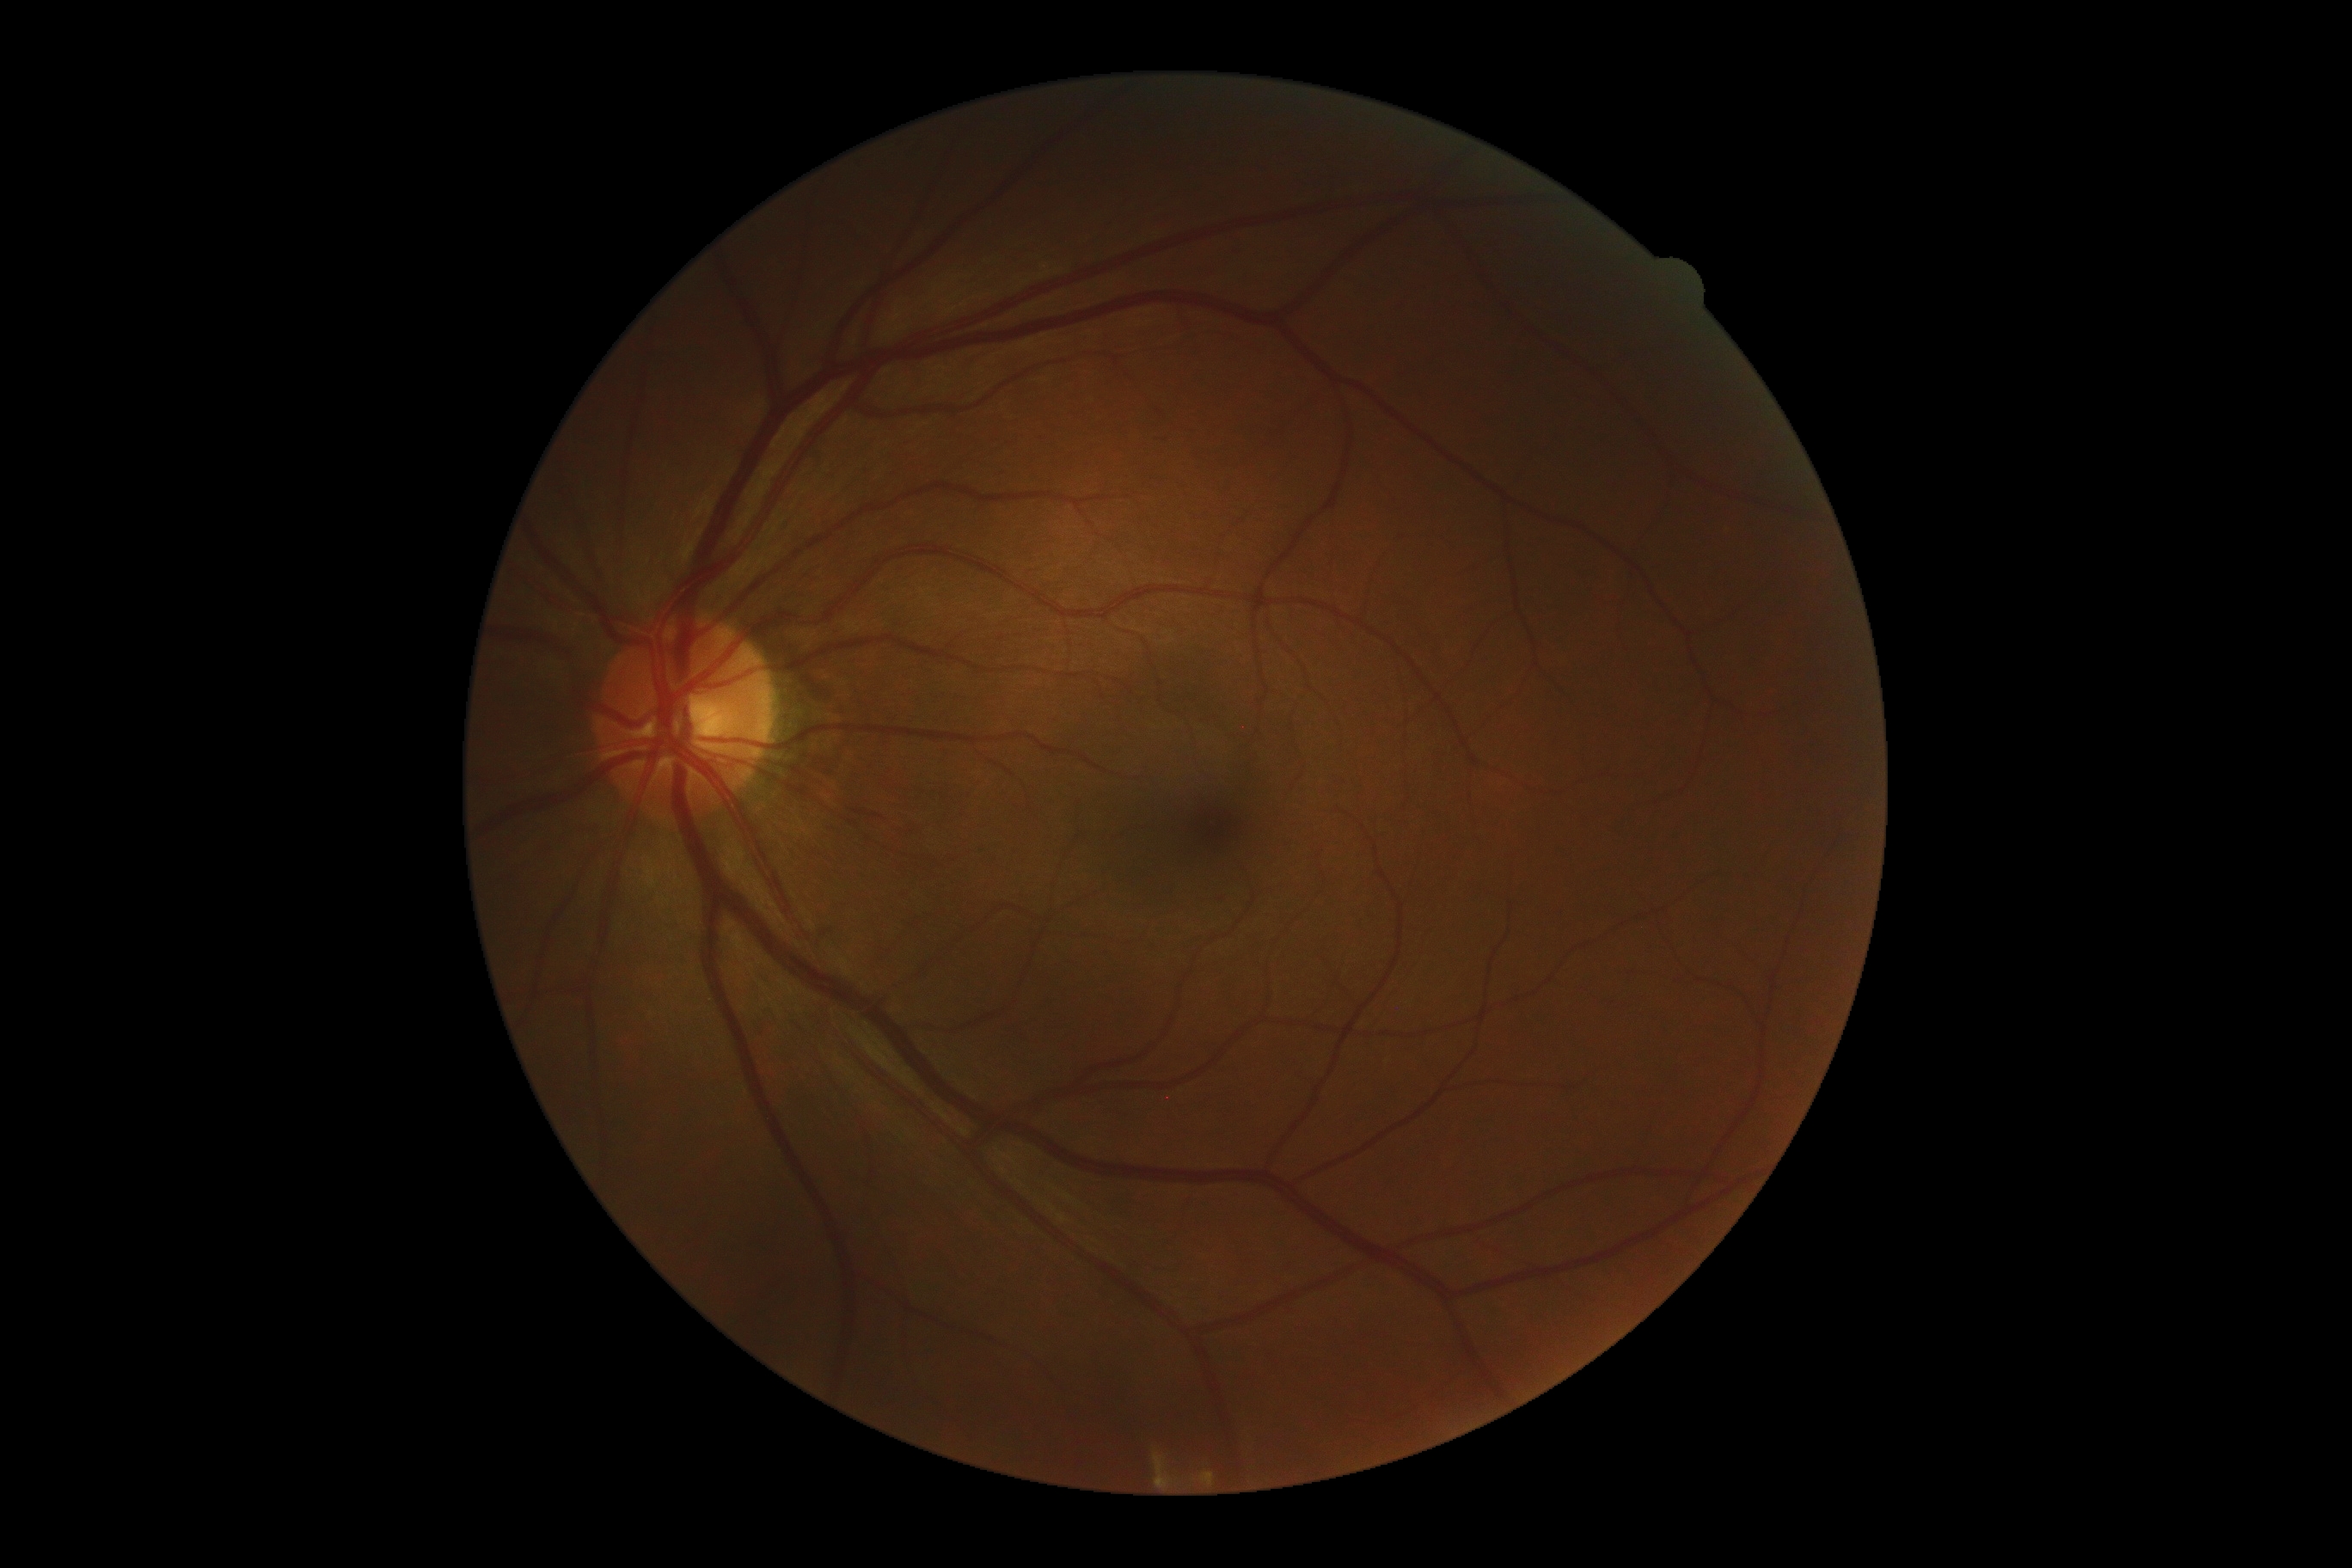
Diabetic retinopathy (DR): grade 0 (no apparent retinopathy) — no visible signs of diabetic retinopathy. No signs of diabetic retinopathy.